Pediatric retinal photograph (wide-field):
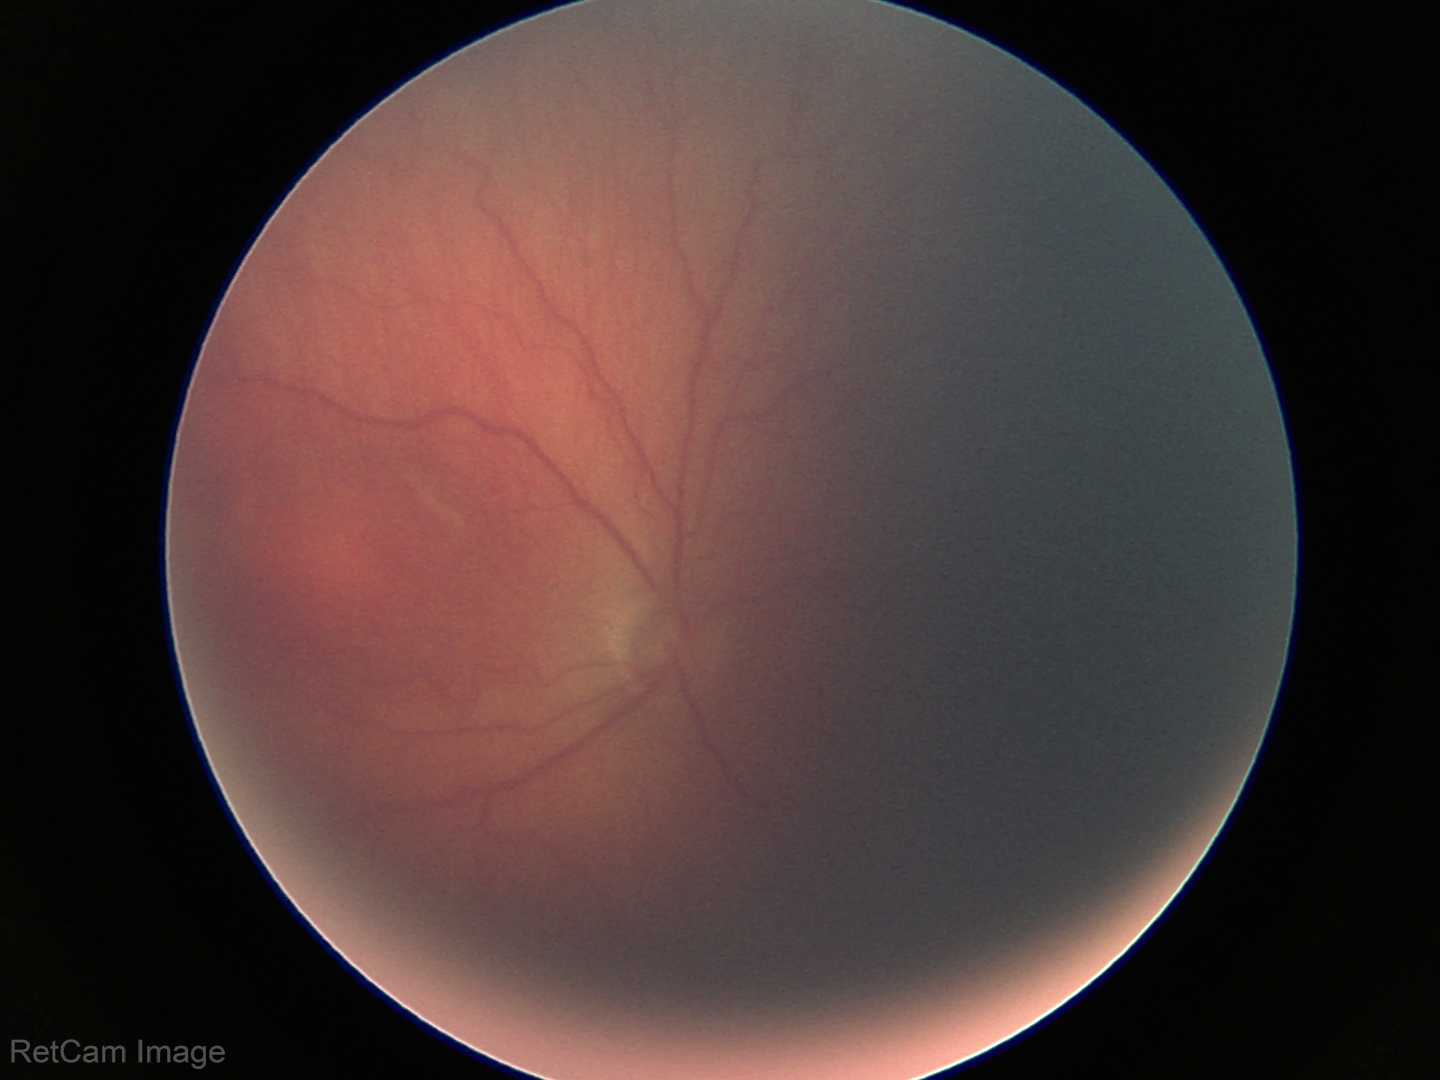
Screening examination consistent with retinopathy of prematurity stage 2. Plus disease absent.